130° field of view (Clarity RetCam 3); wide-field fundus photograph of an infant.
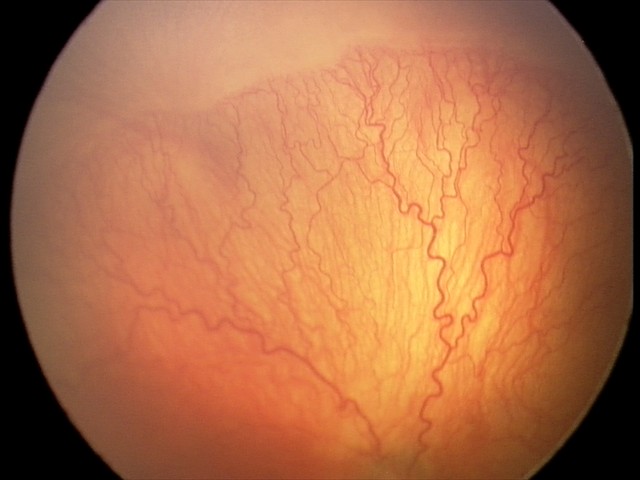 Plus disease: present; impression: aggressive retinopathy of prematurity — rapidly progressive severe ROP with prominent plus disease, often without classic stage progression.